Modified Davis classification: 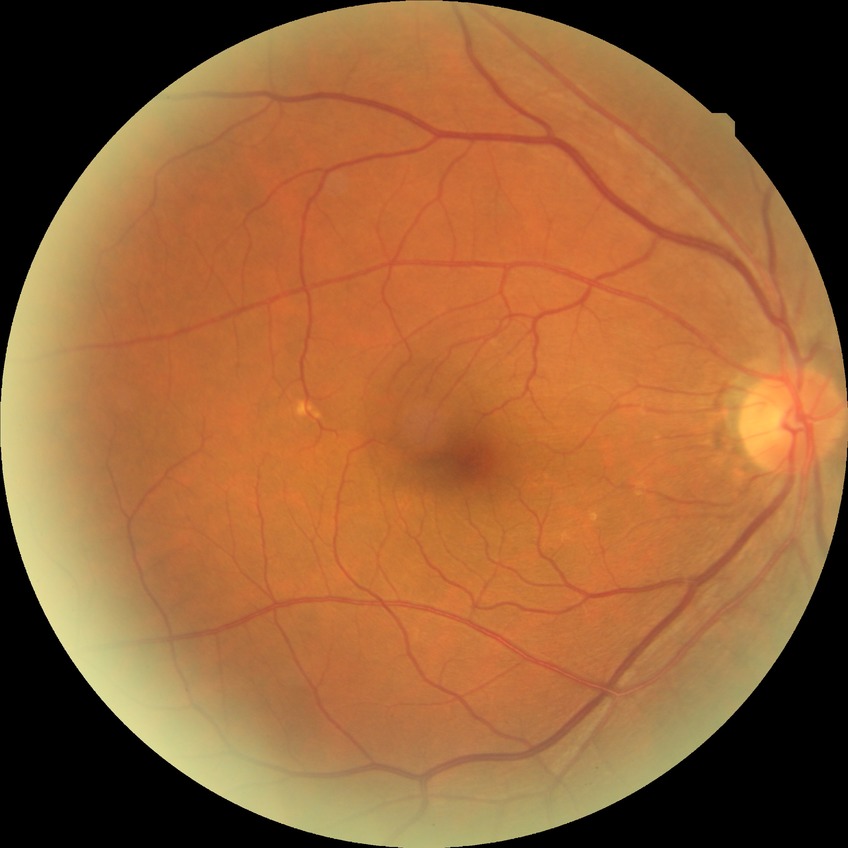
diabetic retinopathy (DR): no diabetic retinopathy (NDR).